Infant wide-field retinal image: 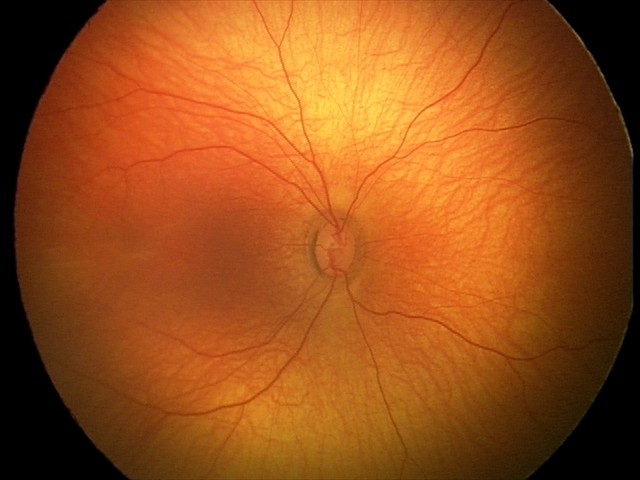 Q: What was the screening finding?
A: normal retinal appearance